Optic nerve head photograph; dilated pupil; FOV 35° before cropping:
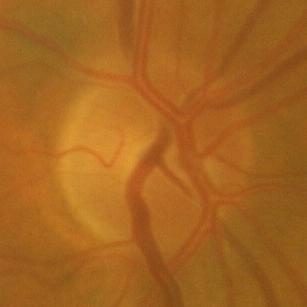 Impression = no glaucomatous optic neuropathy.